Acquired on the Natus RetCam Envision; 1440 x 1080 pixels; wide-field fundus image from infant ROP screening — 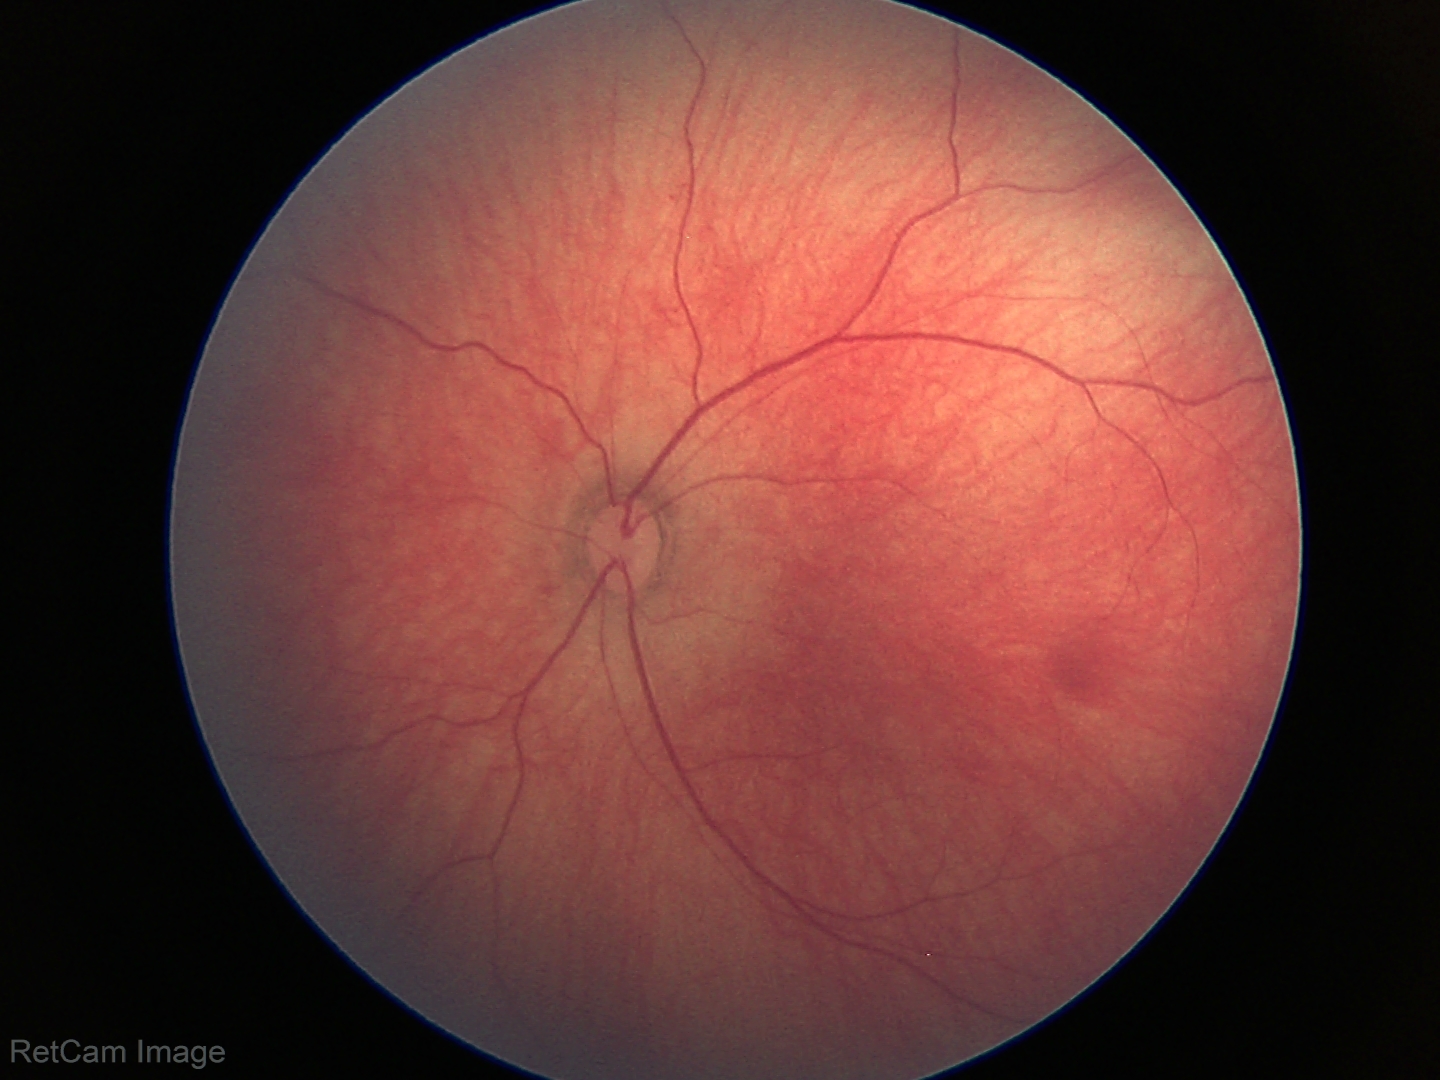

Q: What is the screening diagnosis?
A: physiological retinal finding